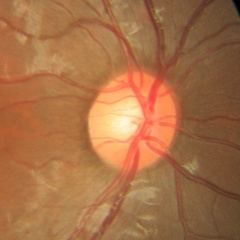 No glaucomatous findings.